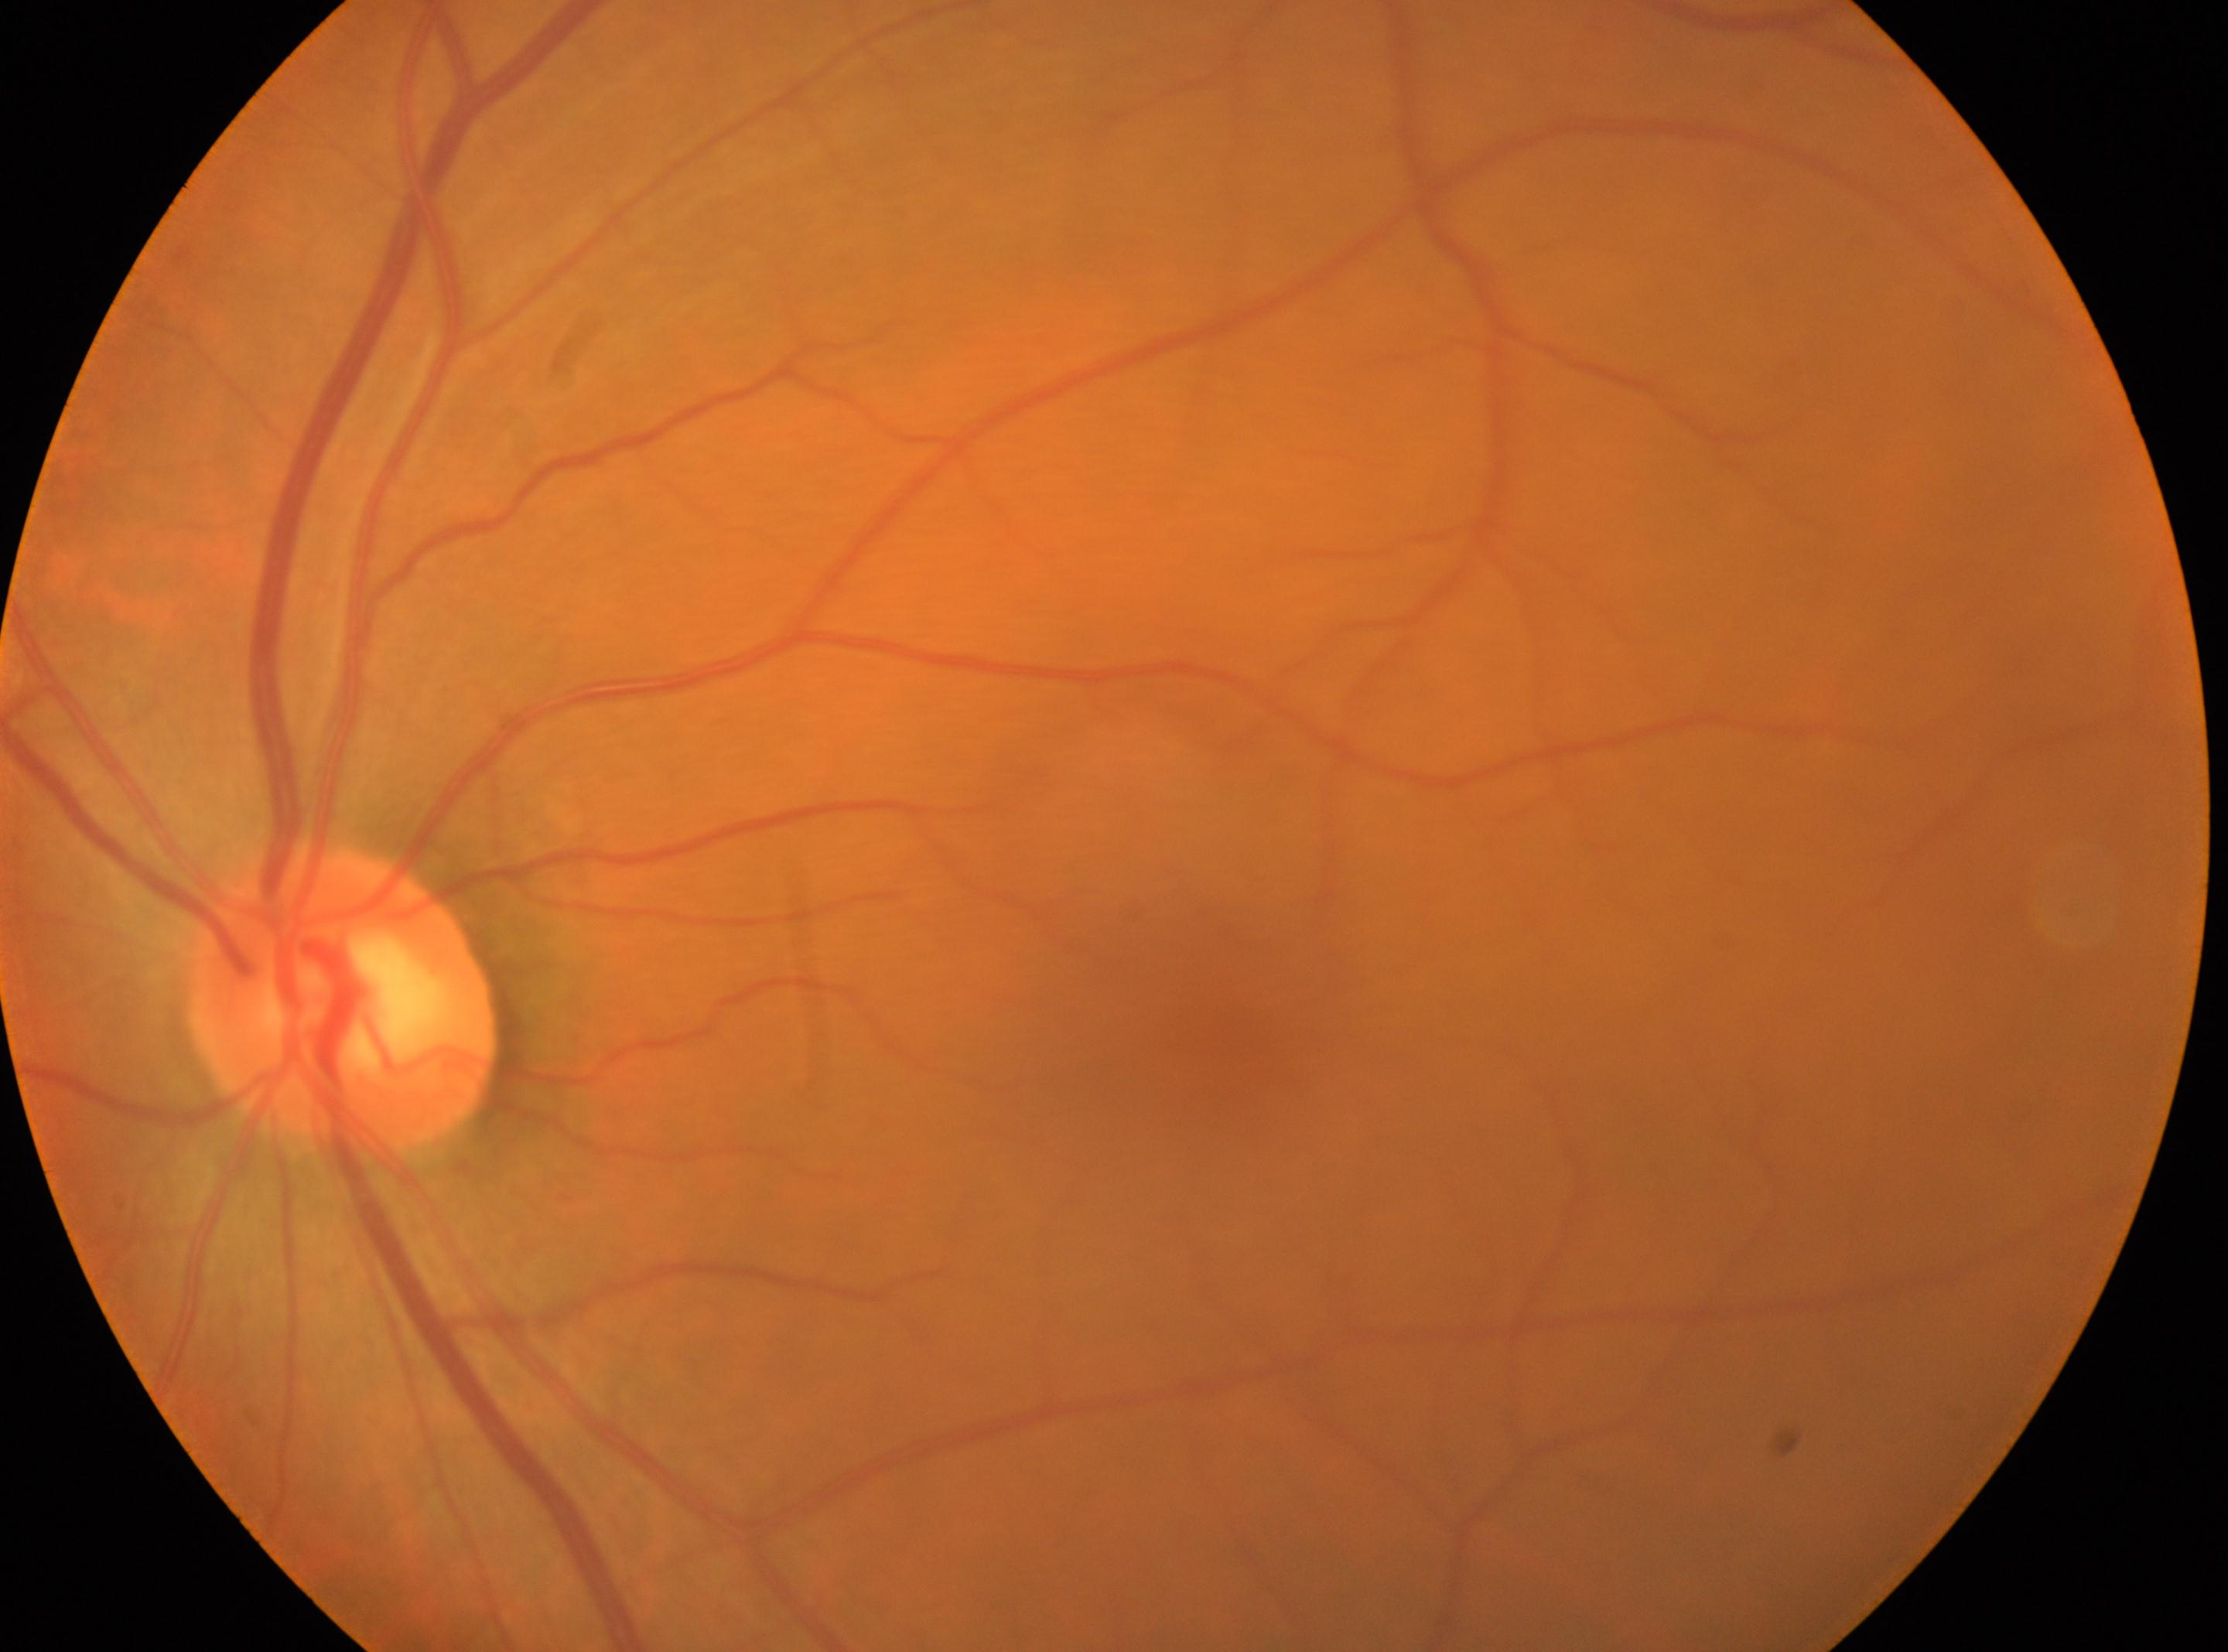

ONH: (341, 999).
Diabetic retinopathy severity is grade 0 (no apparent retinopathy).
The image shows the oculus sinister.
Foveal center: (1224, 1036).